Nonmydriatic. Modified Davis classification — 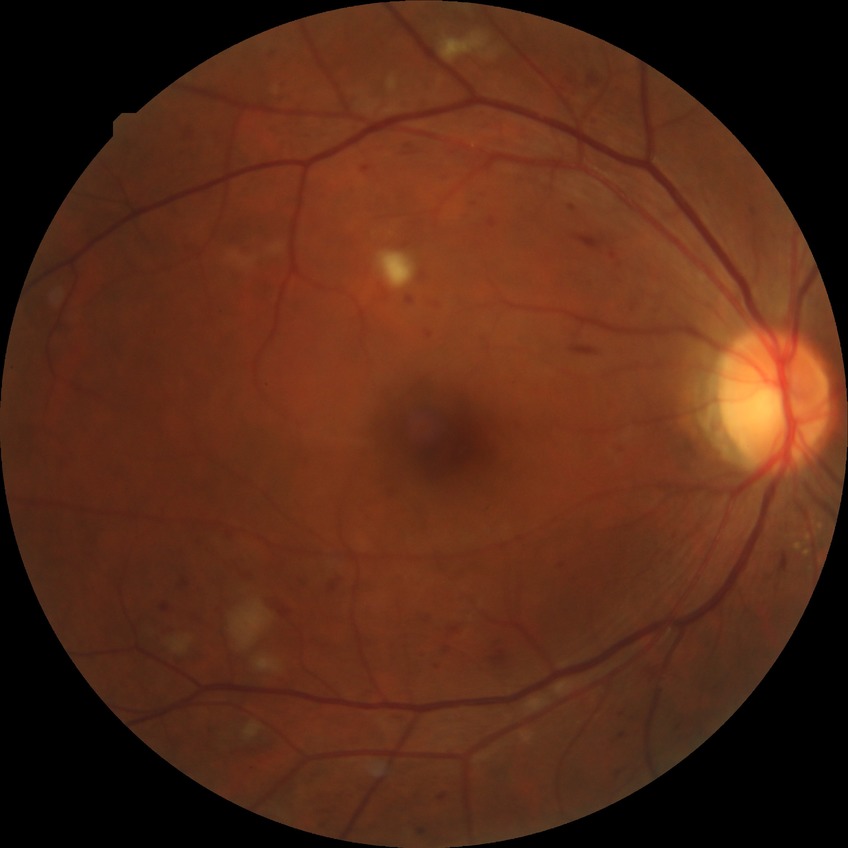

Davis grading: pre-proliferative diabetic retinopathy; DR class: non-proliferative diabetic retinopathy.